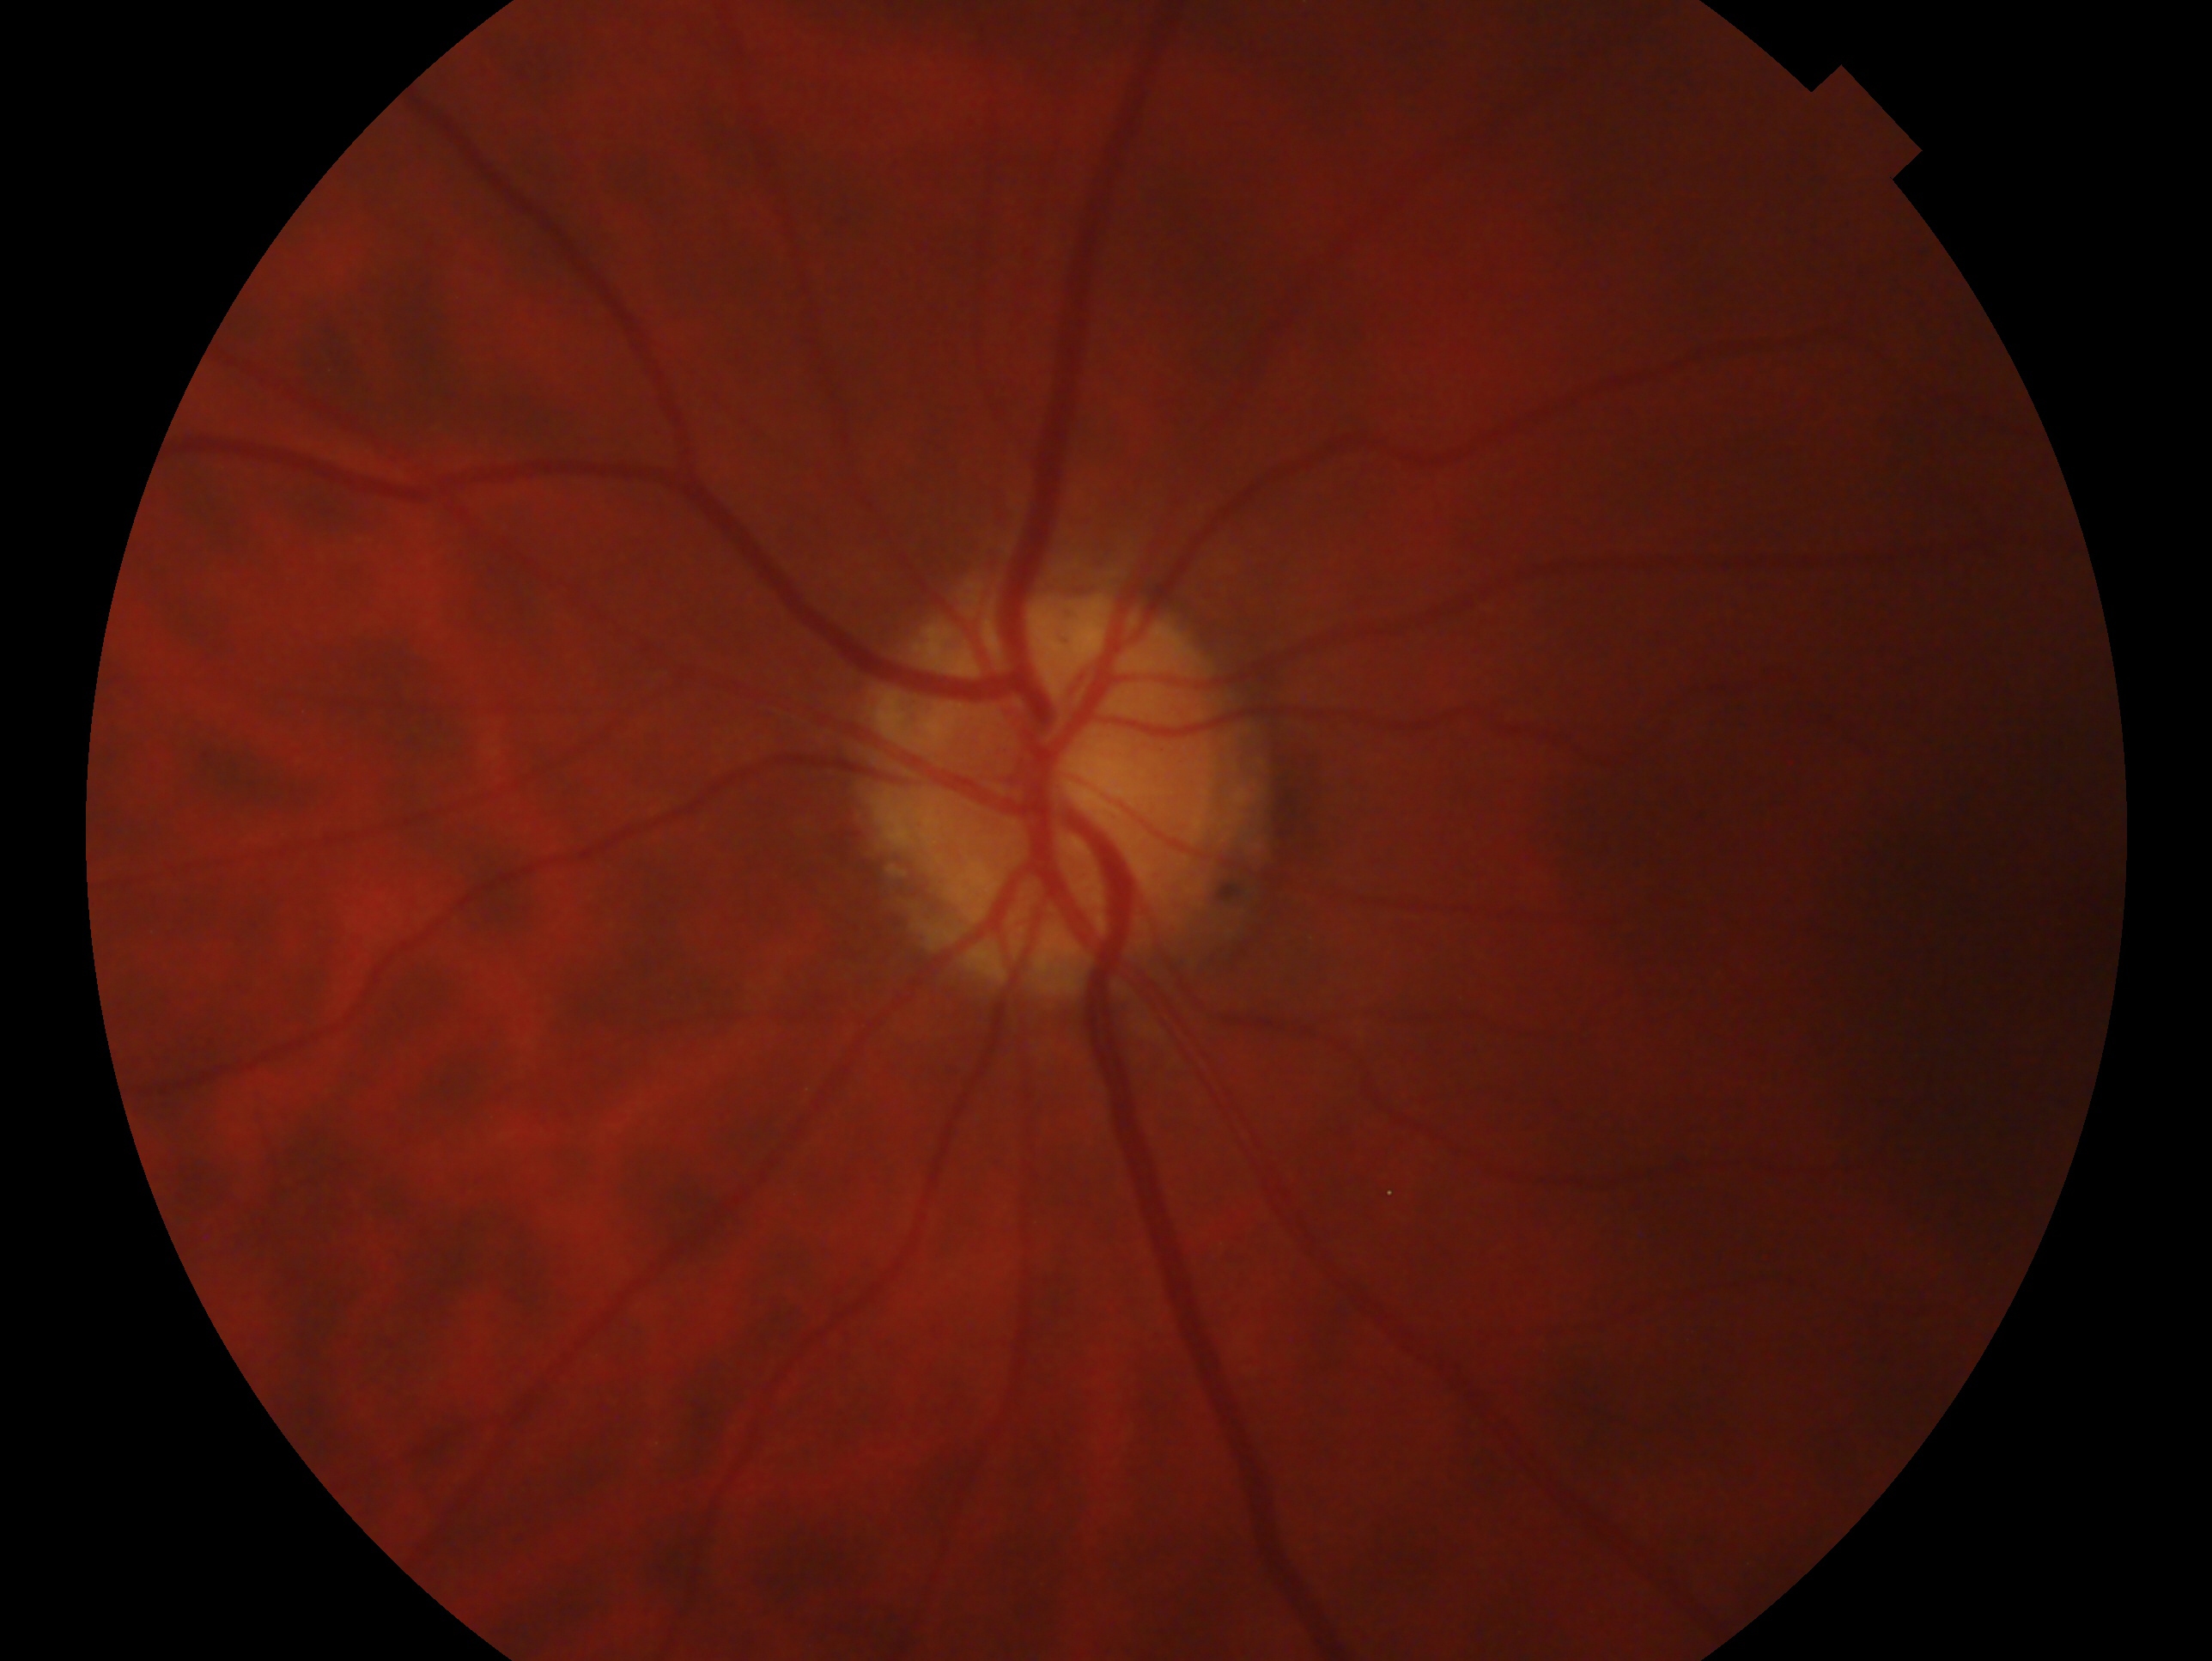 Eye: left eye. Impression — consistent with glaucoma.